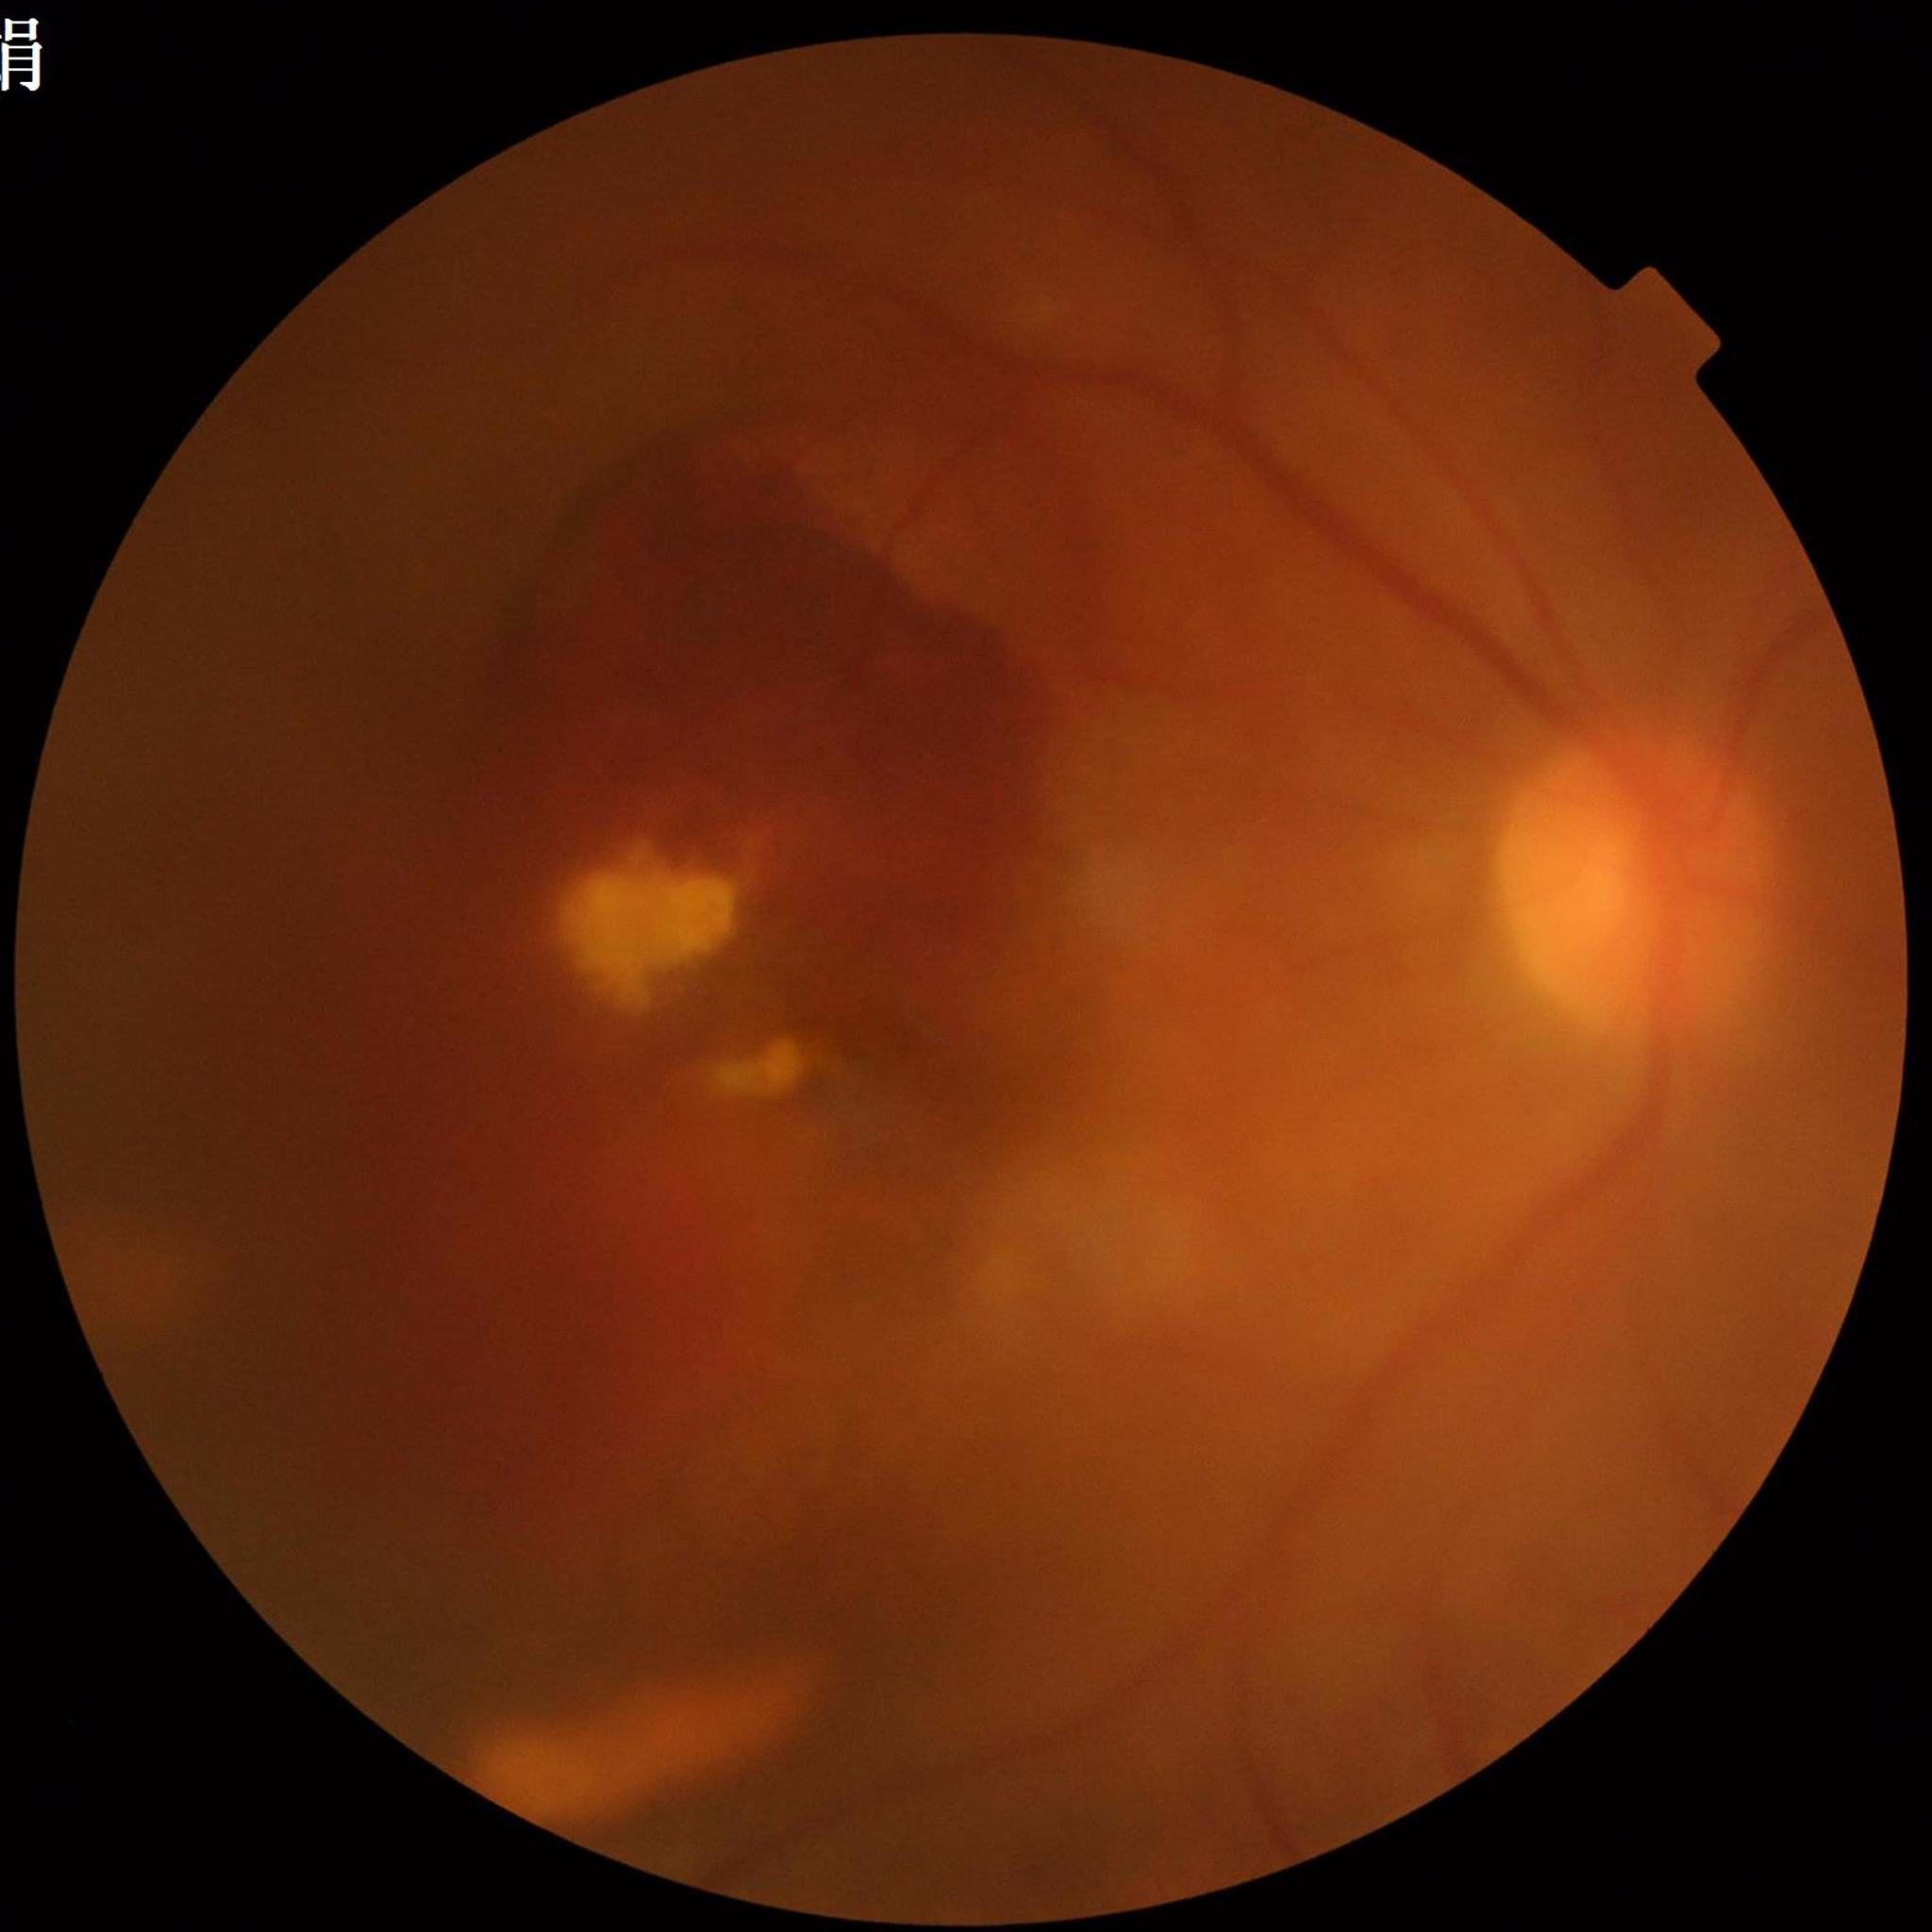
Image quality: suboptimal — blur, illumination/color distortion.
From a patient with age-related macular degeneration (AMD).